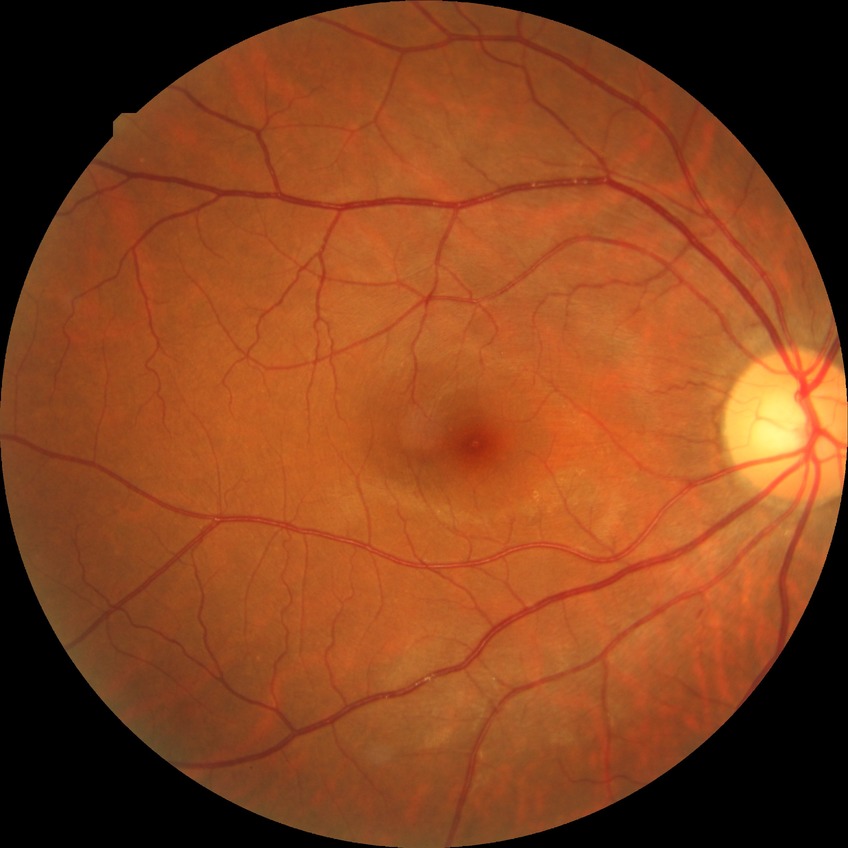
diabetic retinopathy (DR) = NDR (no diabetic retinopathy).